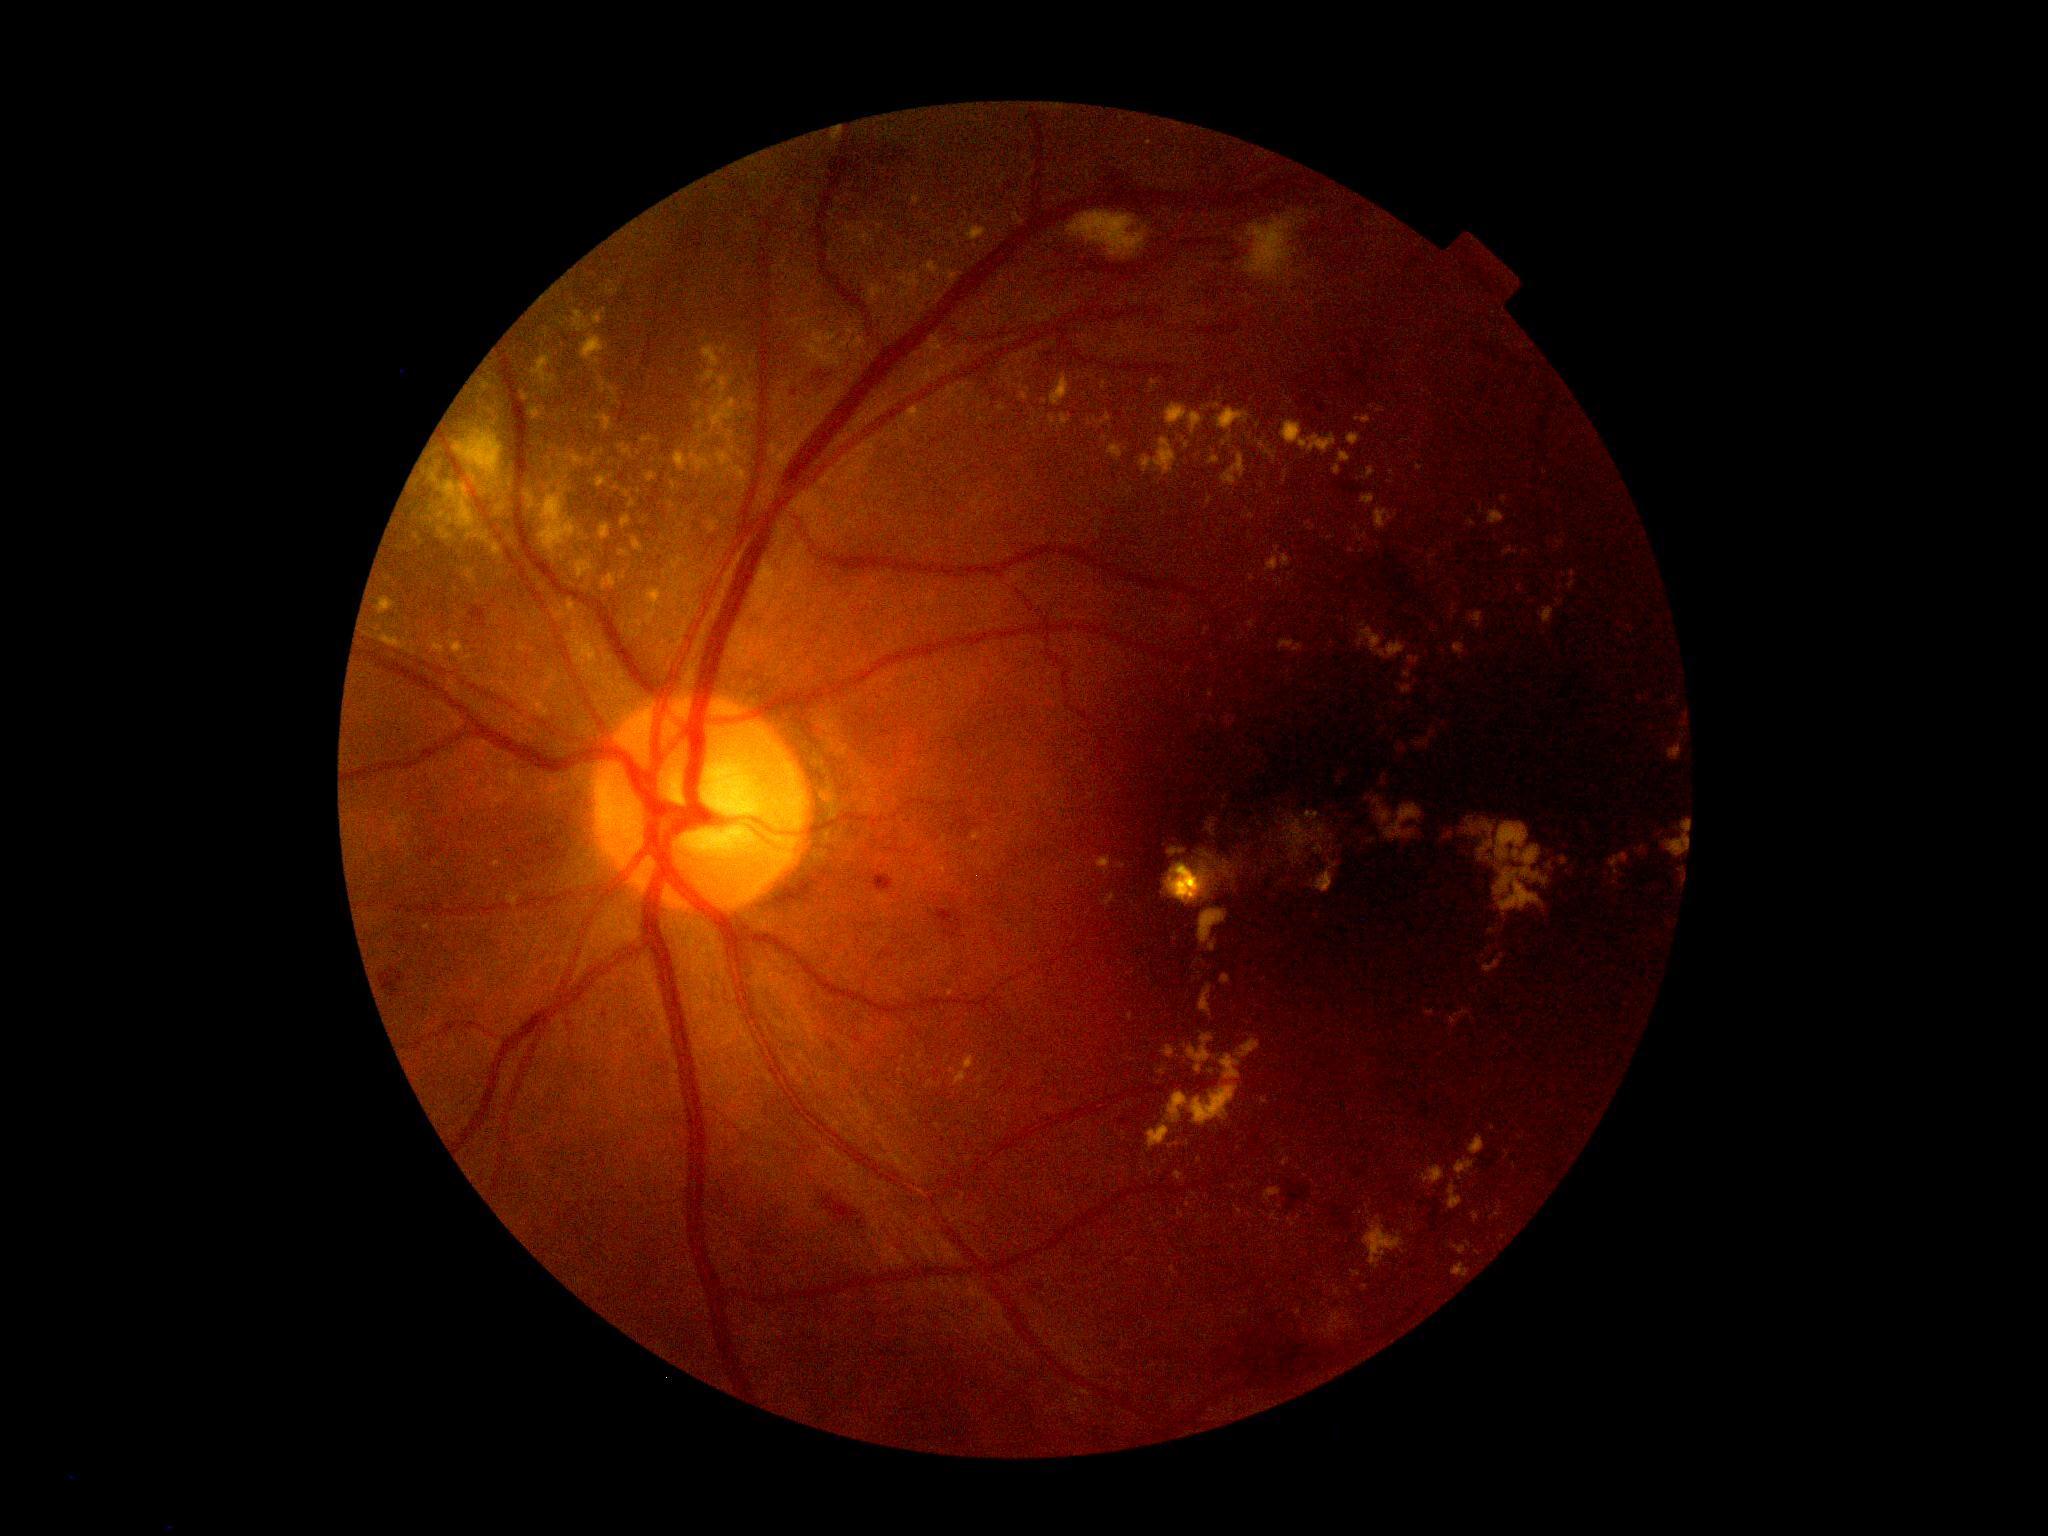

DR stage=moderate non-proliferative diabetic retinopathy (grade 2) — more than just microaneurysms but less than severe NPDR, DR class=non-proliferative diabetic retinopathy.